848x848px, 45° FOV — 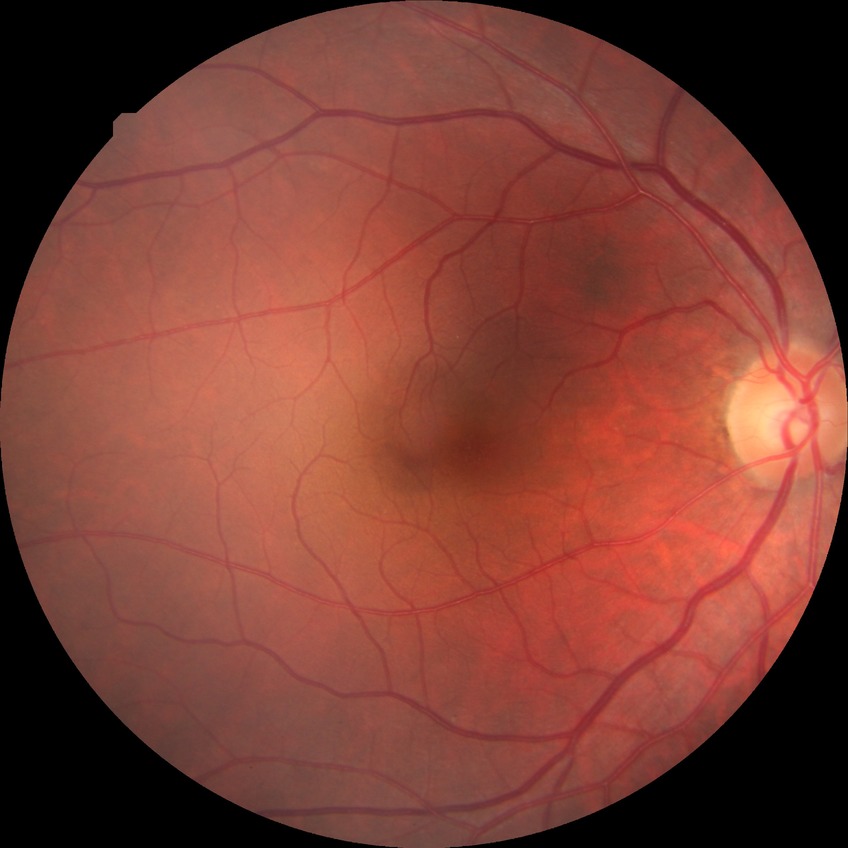
diabetic retinopathy stage@no diabetic retinopathy.